Pediatric wide-field fundus photograph
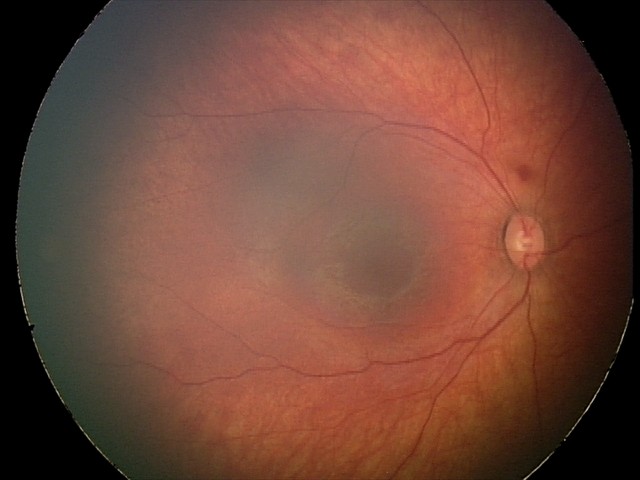

Screening series with retinal hemorrhages.